Retinal fundus photograph — 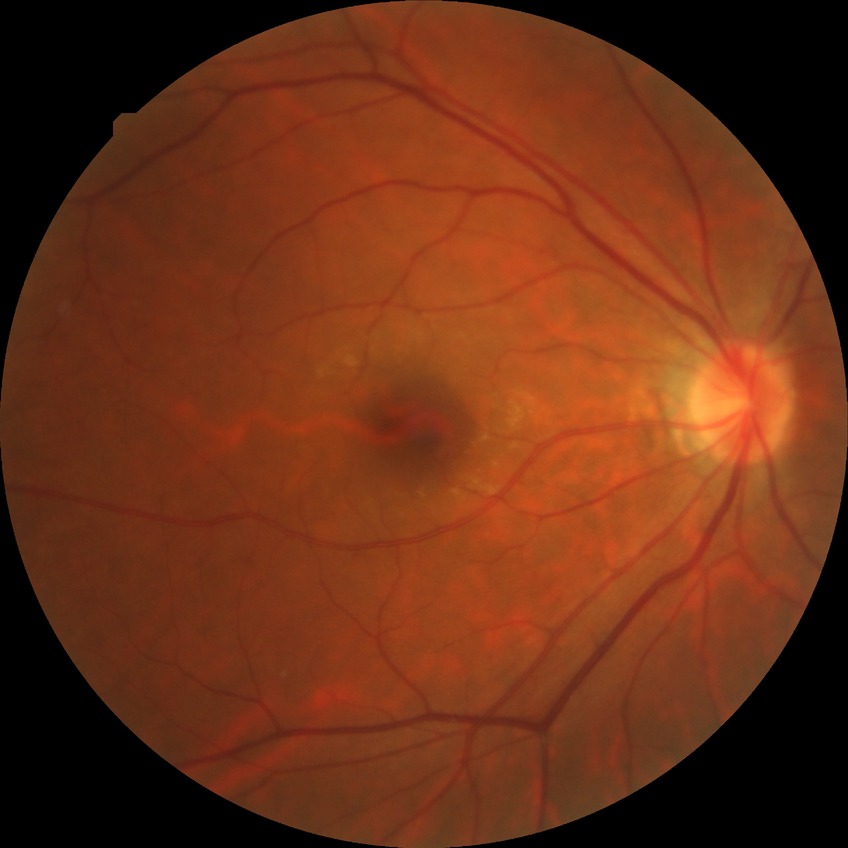 modified Davis classification: no diabetic retinopathy.